240 by 240 pixels · CFP — 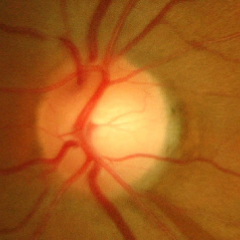

Q: Glaucoma assessment?
A: Yes — advanced glaucomatous optic neuropathy.